Fundus photo: 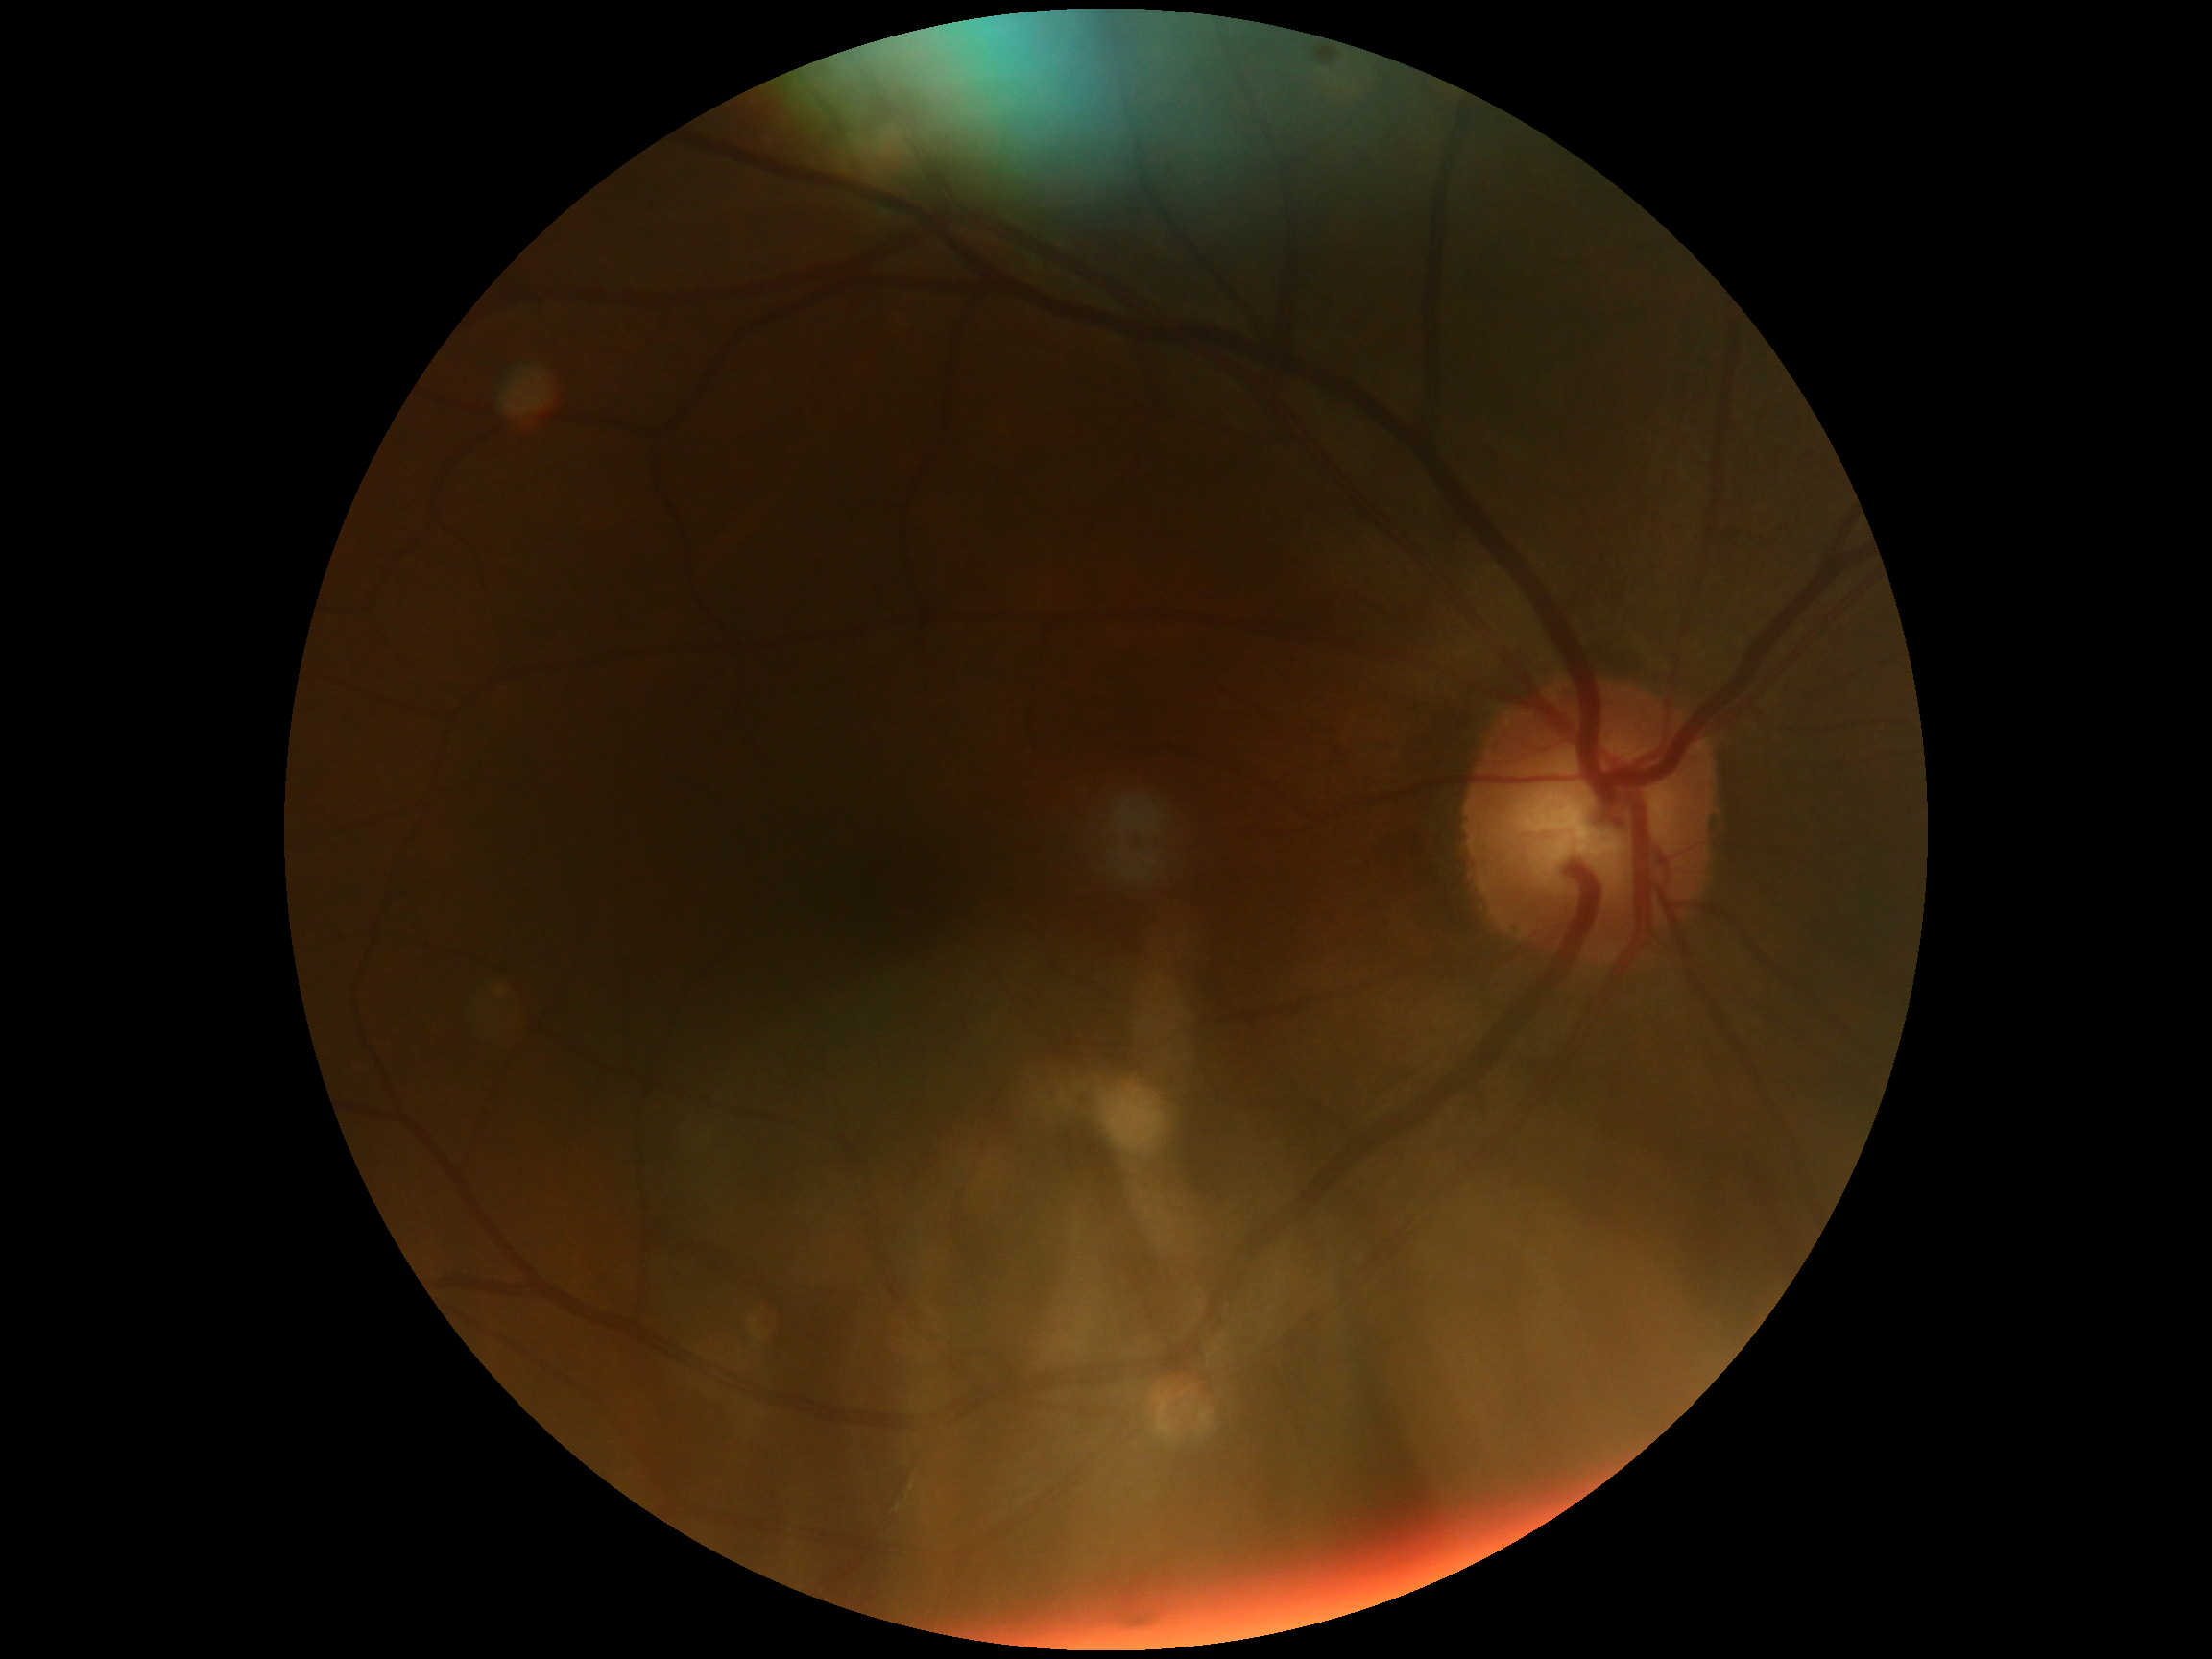 No DR findings.
DR grade: 0.